Nonmydriatic fundus photograph; Davis DR grading: 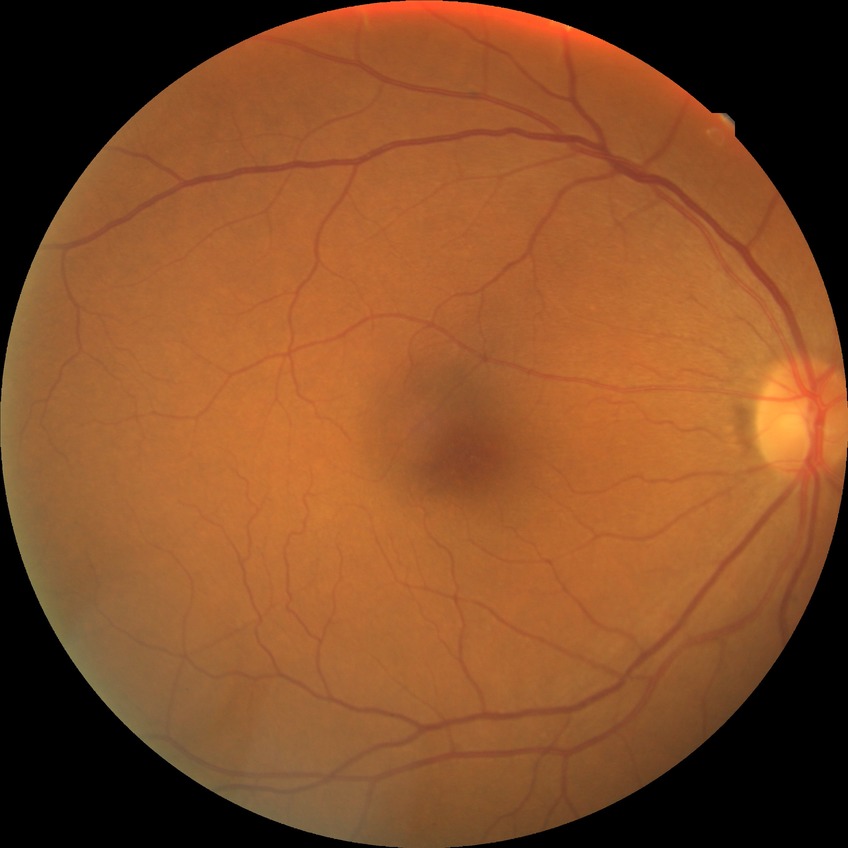

Diabetic retinopathy stage is no diabetic retinopathy.